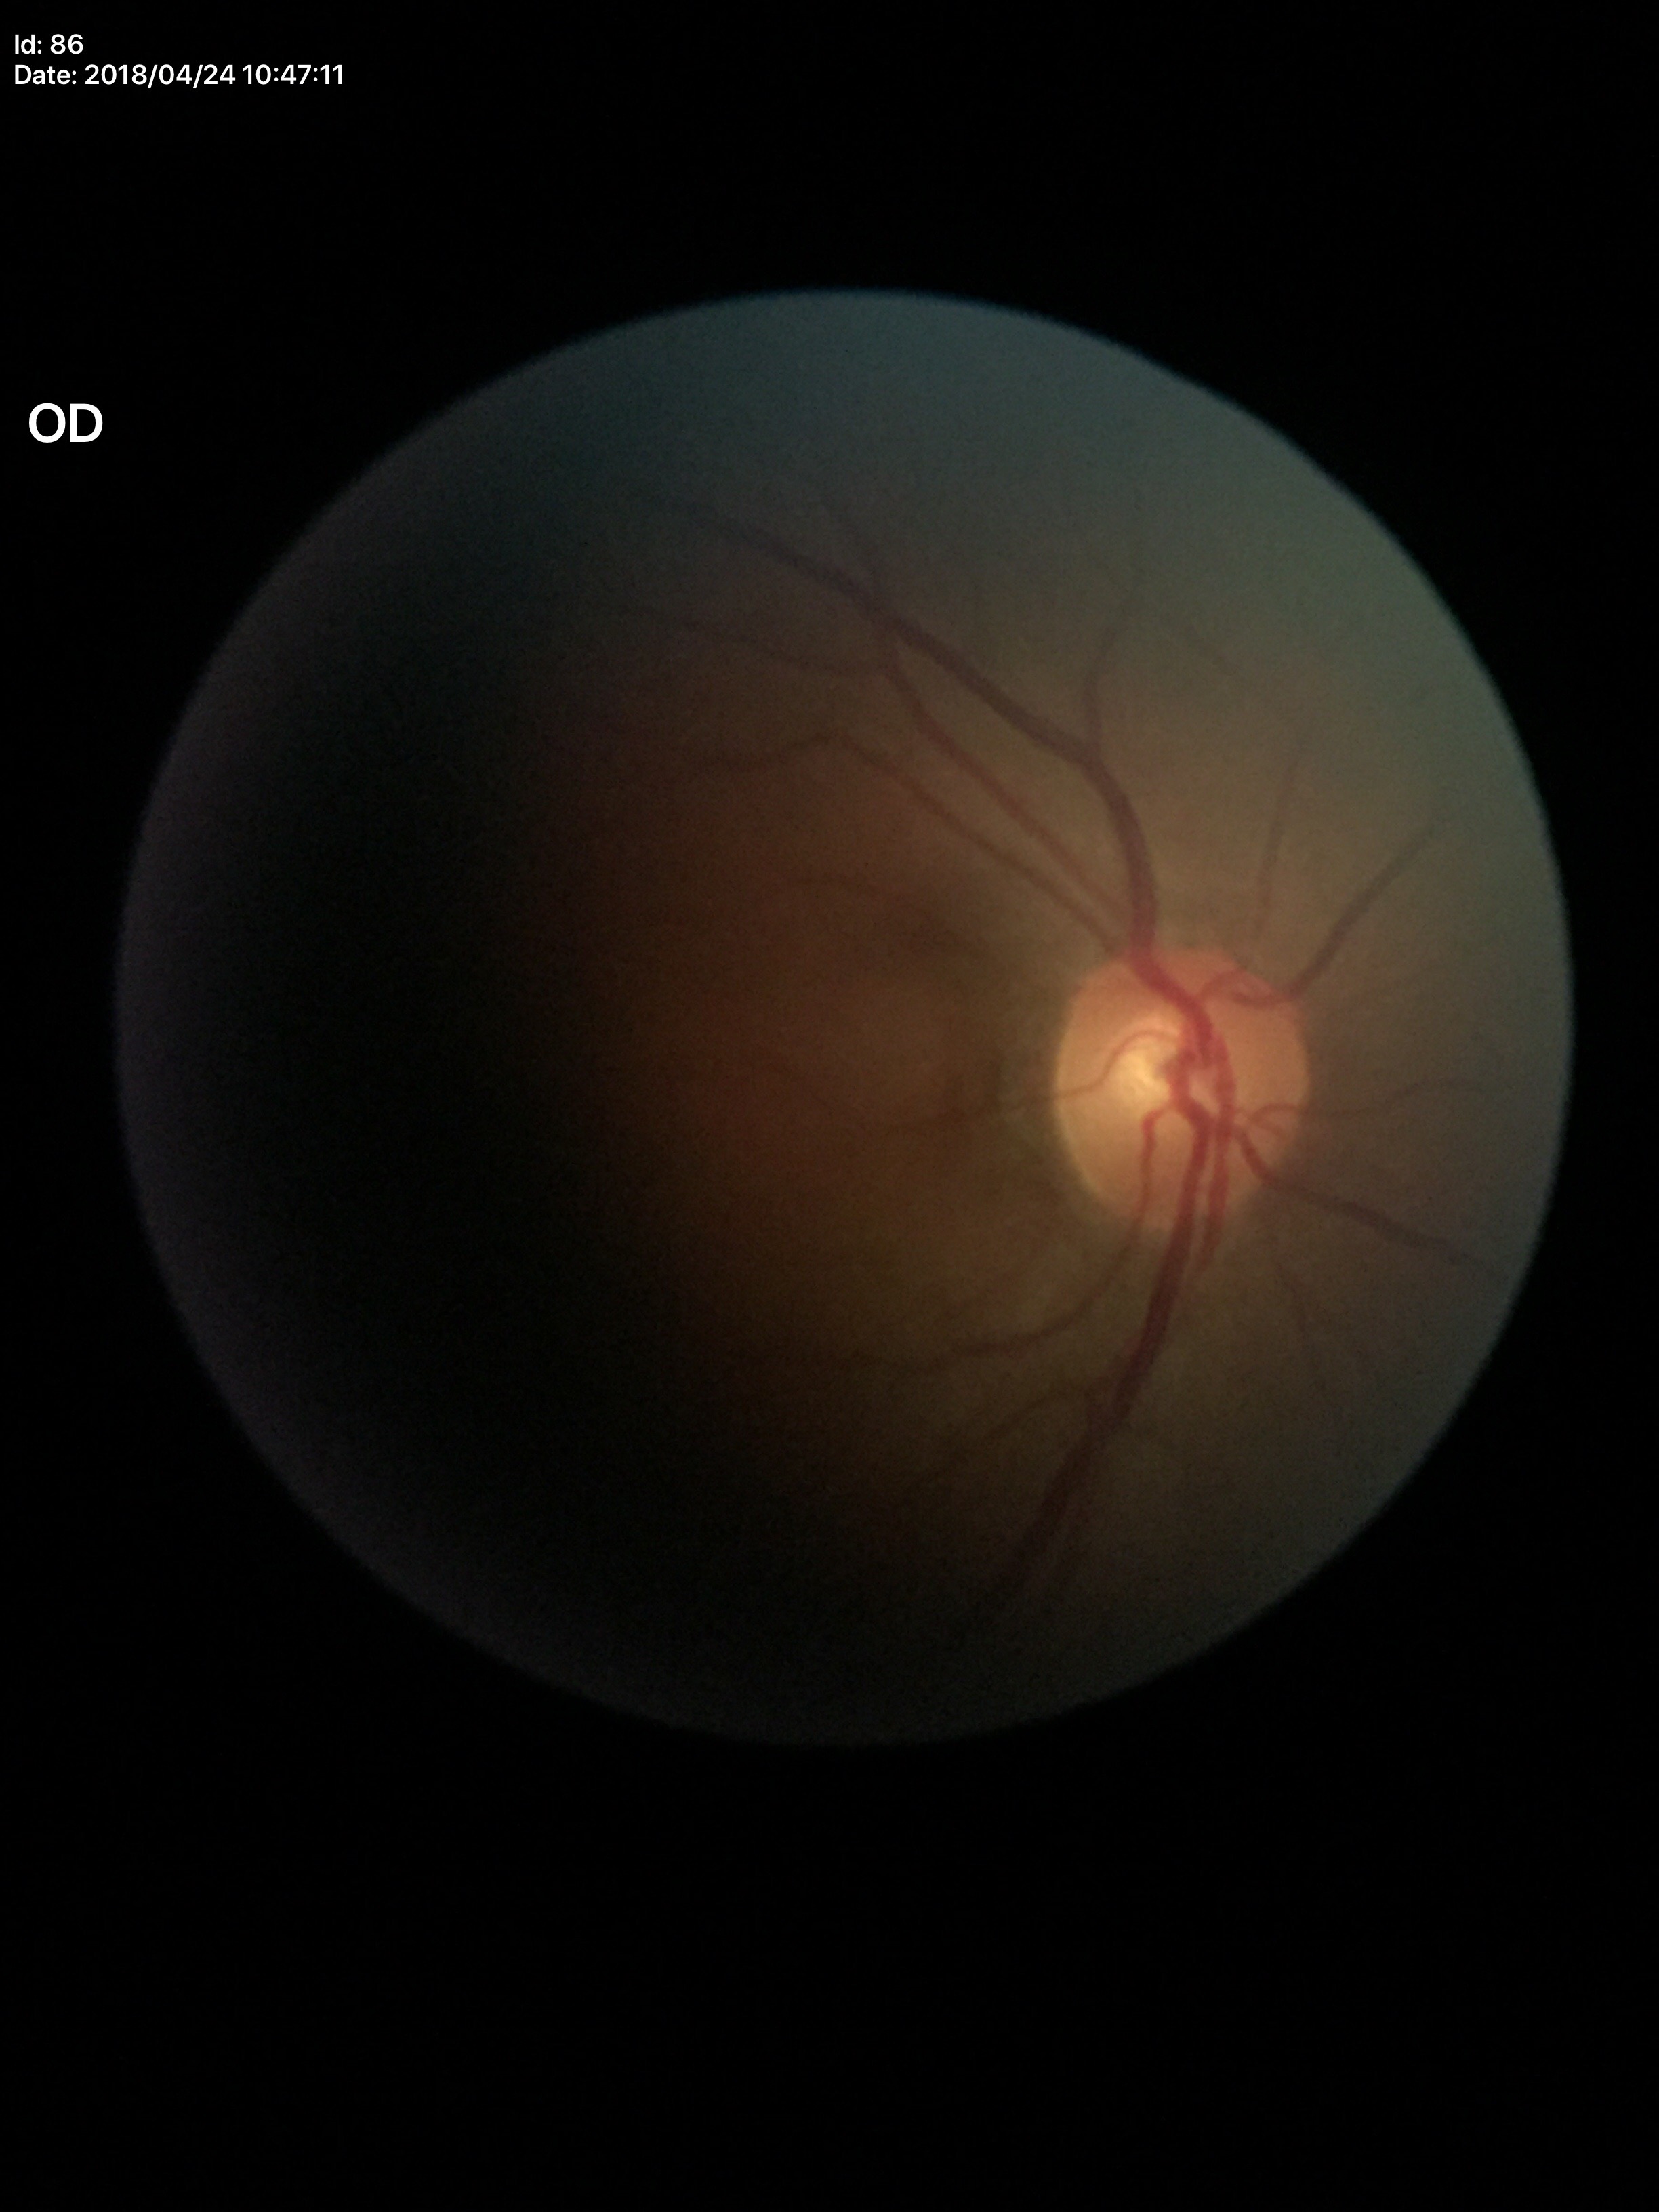
Vertical C/D ratio (VCDR) of 0.52. Not suspicious for glaucoma (unanimous normal call). Horizontal cup-to-disc ratio (HCDR) is 0.52.